2048 x 1536 pixels, fundus photo
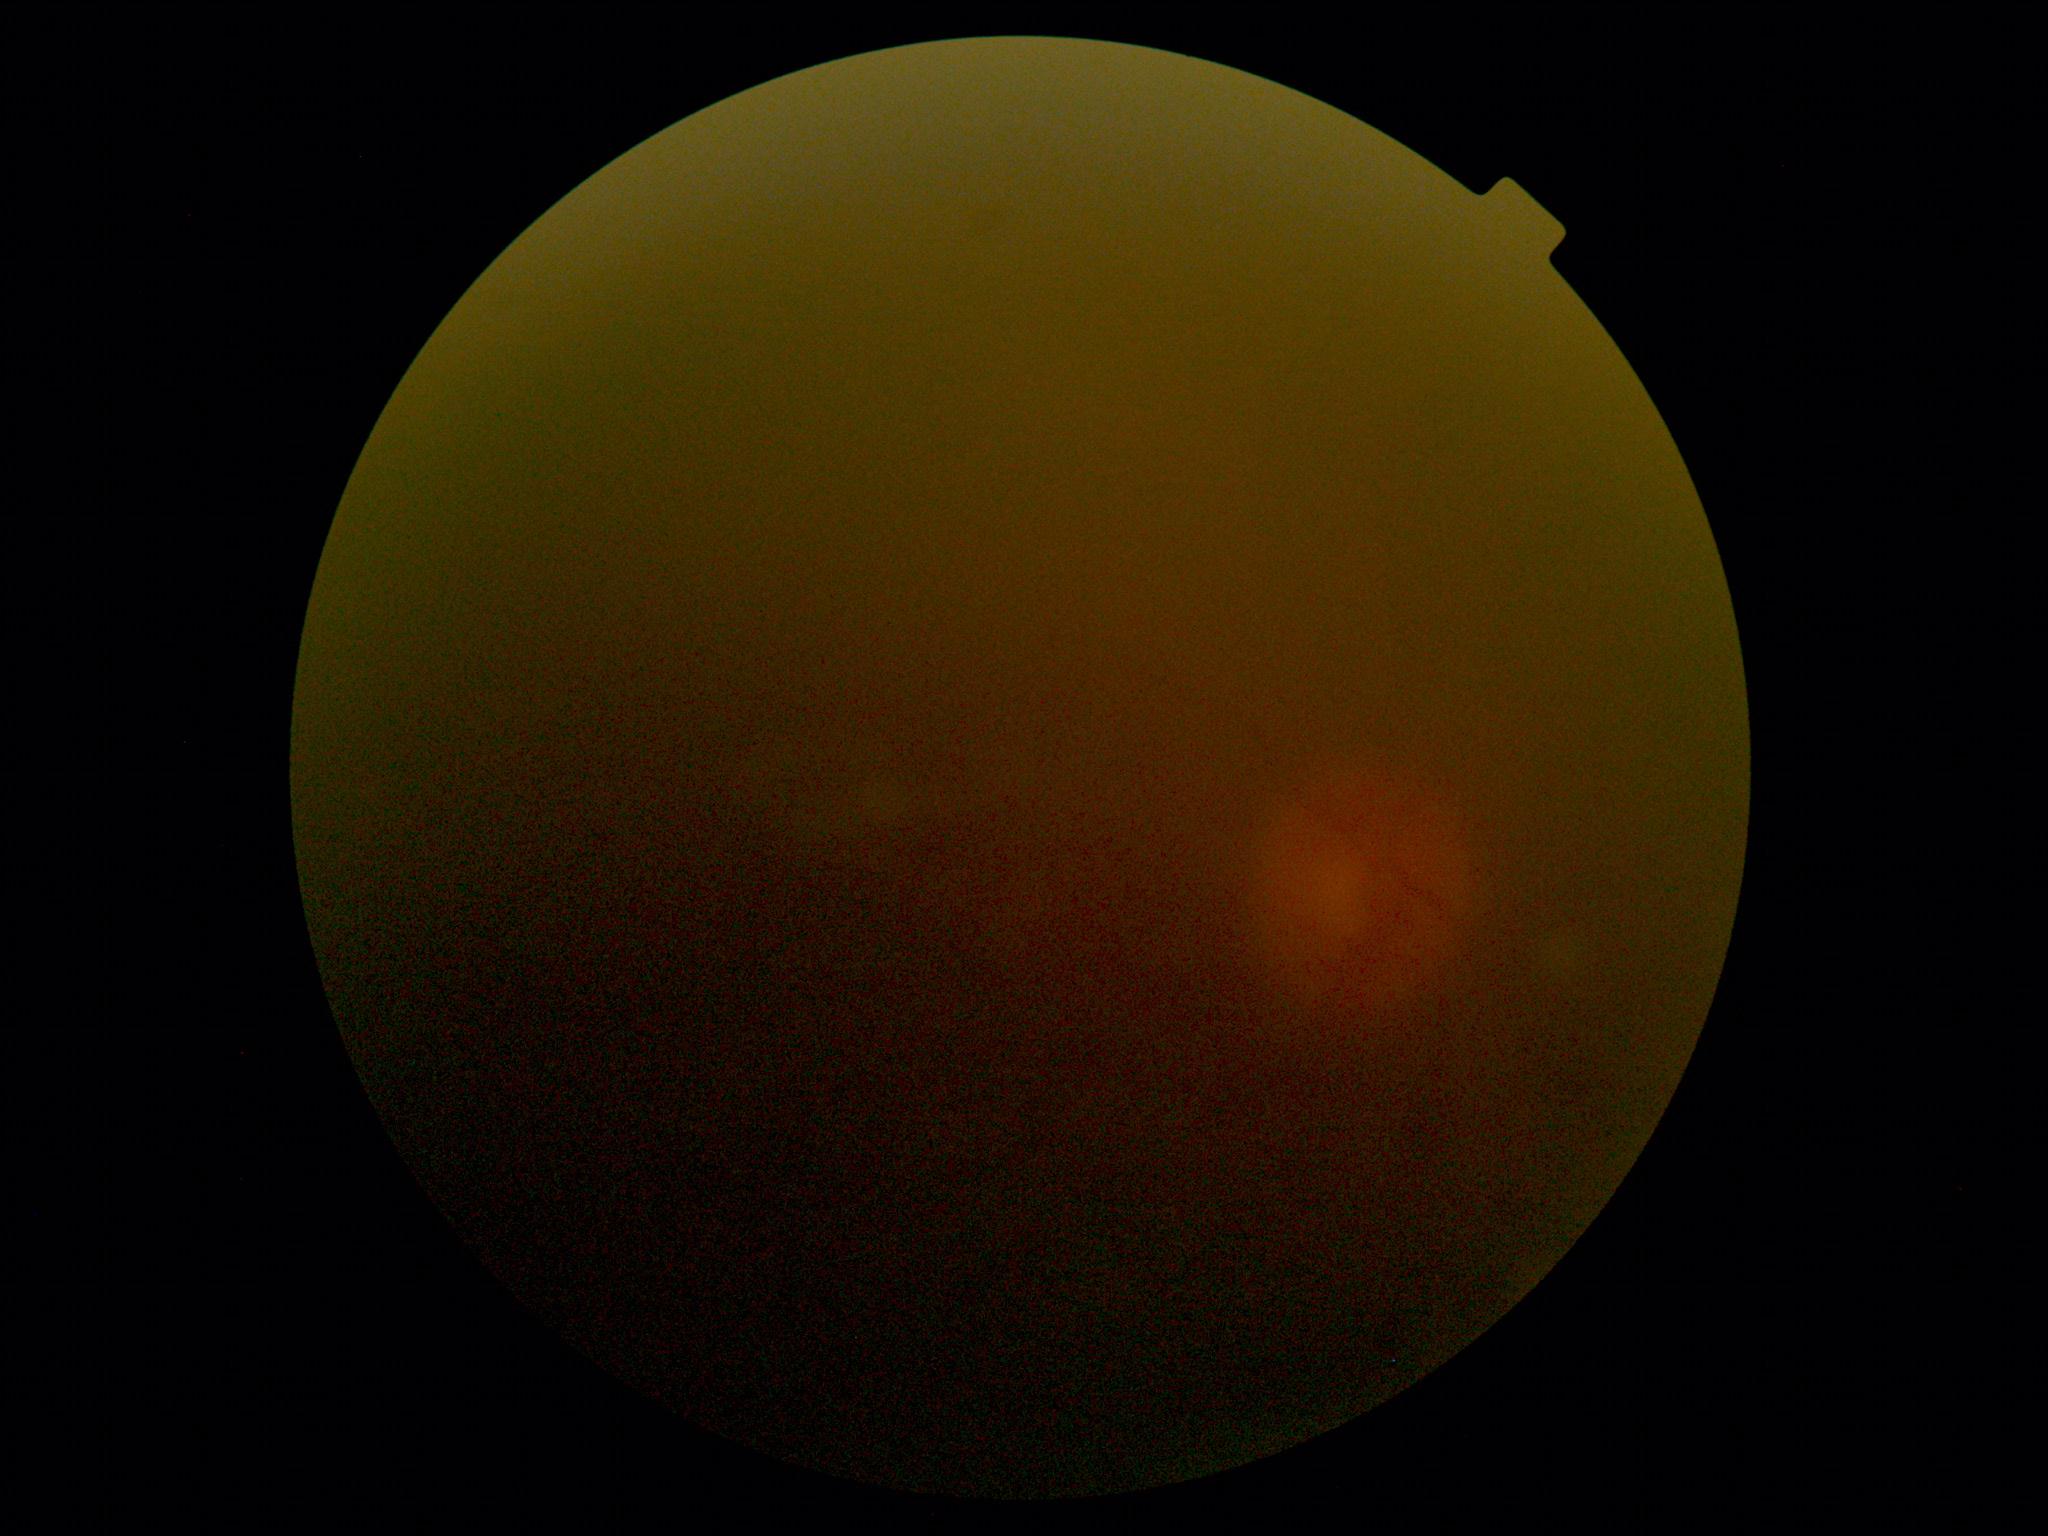 Findings:
• image quality: insufficient
• DR grade: ungradable